45-degree field of view:
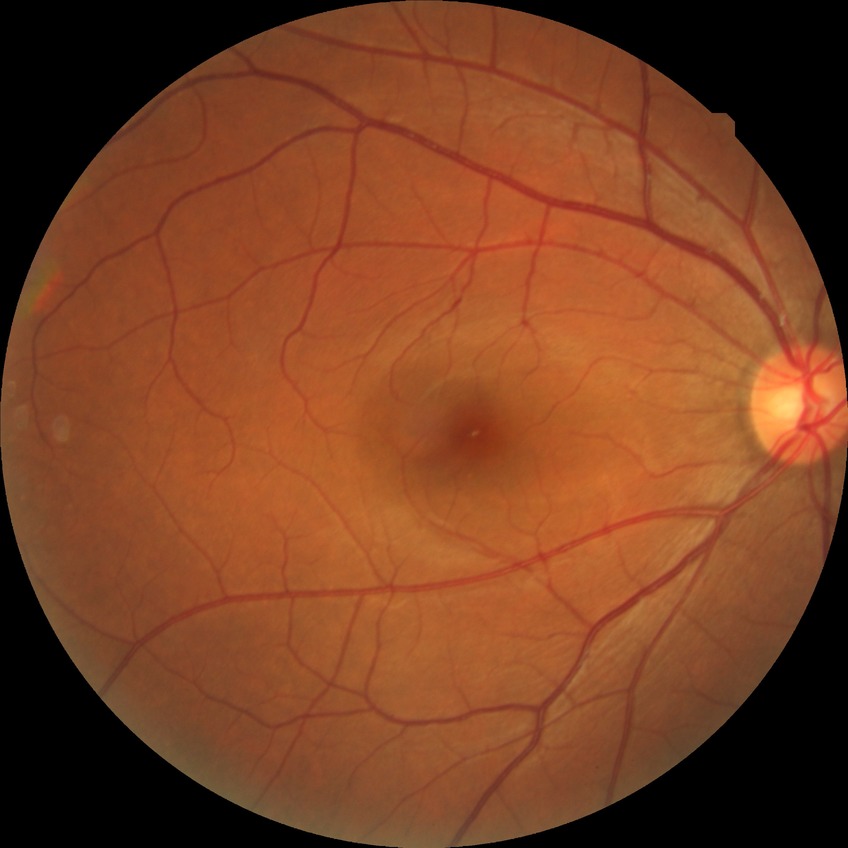 Diabetic retinopathy (DR): NDR (no diabetic retinopathy).